Captured with the Phoenix ICON (100° field of view) · infant wide-field retinal image
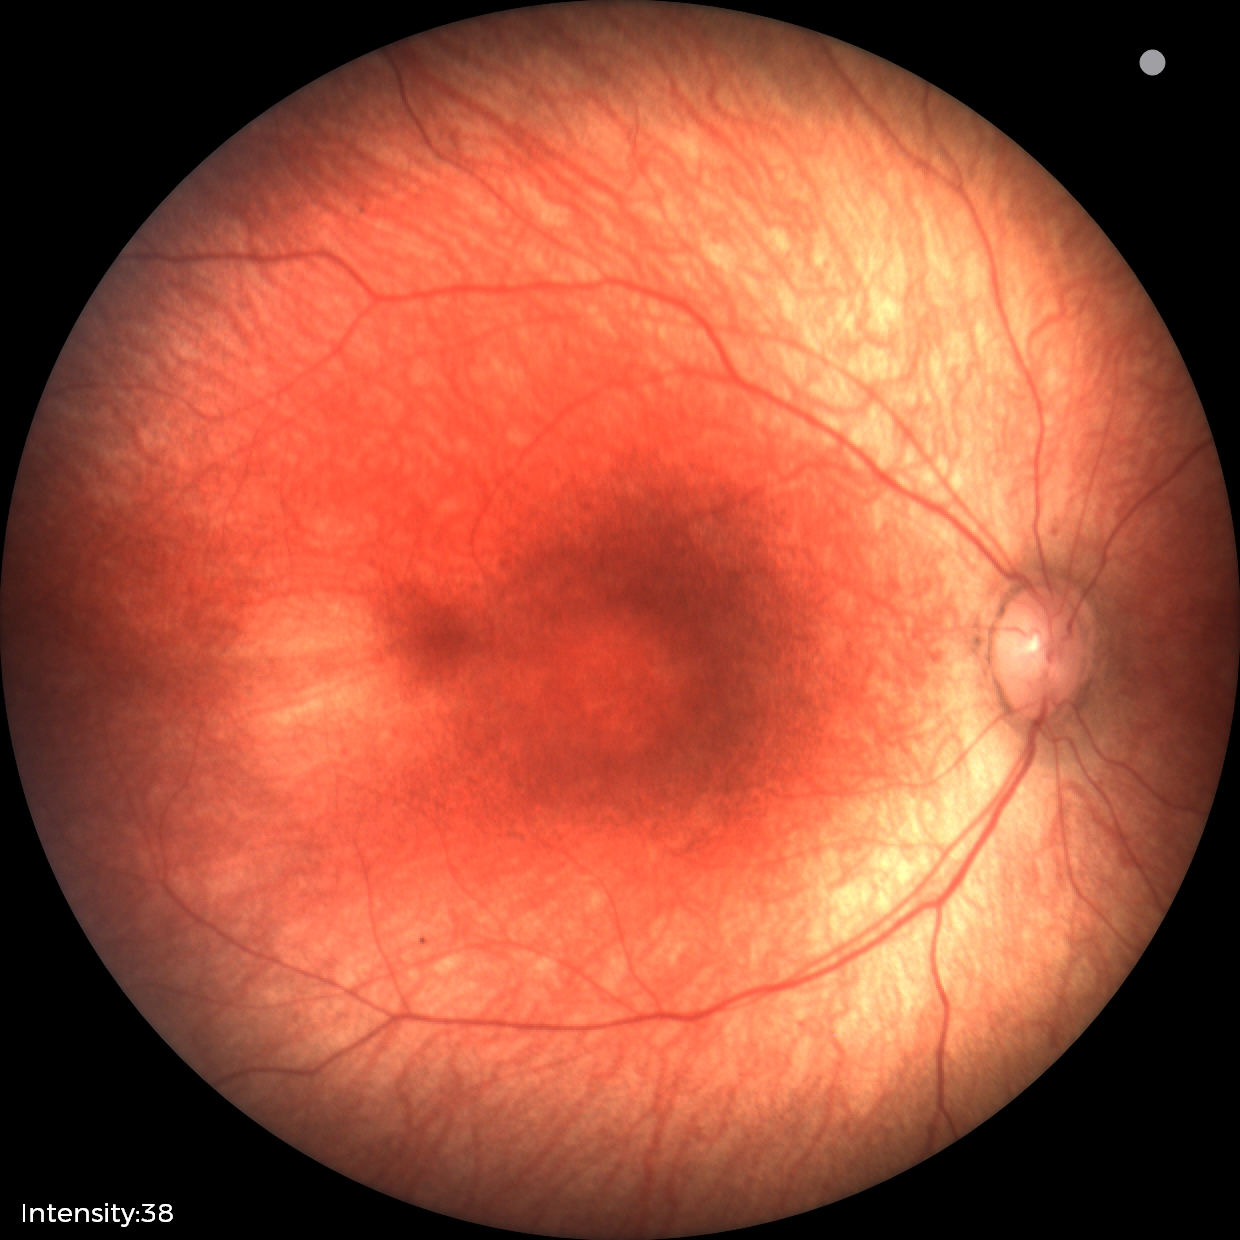

Examination with physiological retinal findings.